Wide-field contact fundus photograph of an infant — 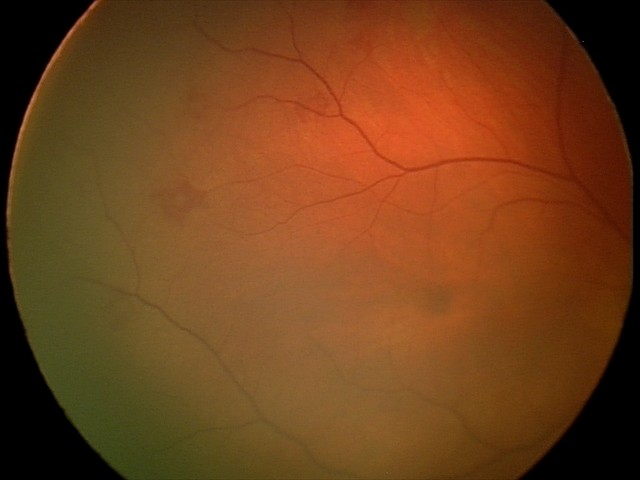

Screening diagnosis: retinal hemorrhages.